Image size 640x480. Wide-field fundus photograph from neonatal ROP screening.
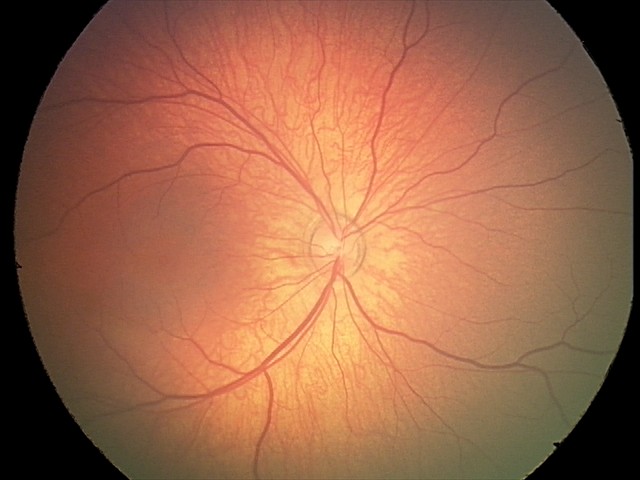
Assessment: normal.